45° field of view, 2352x1568: 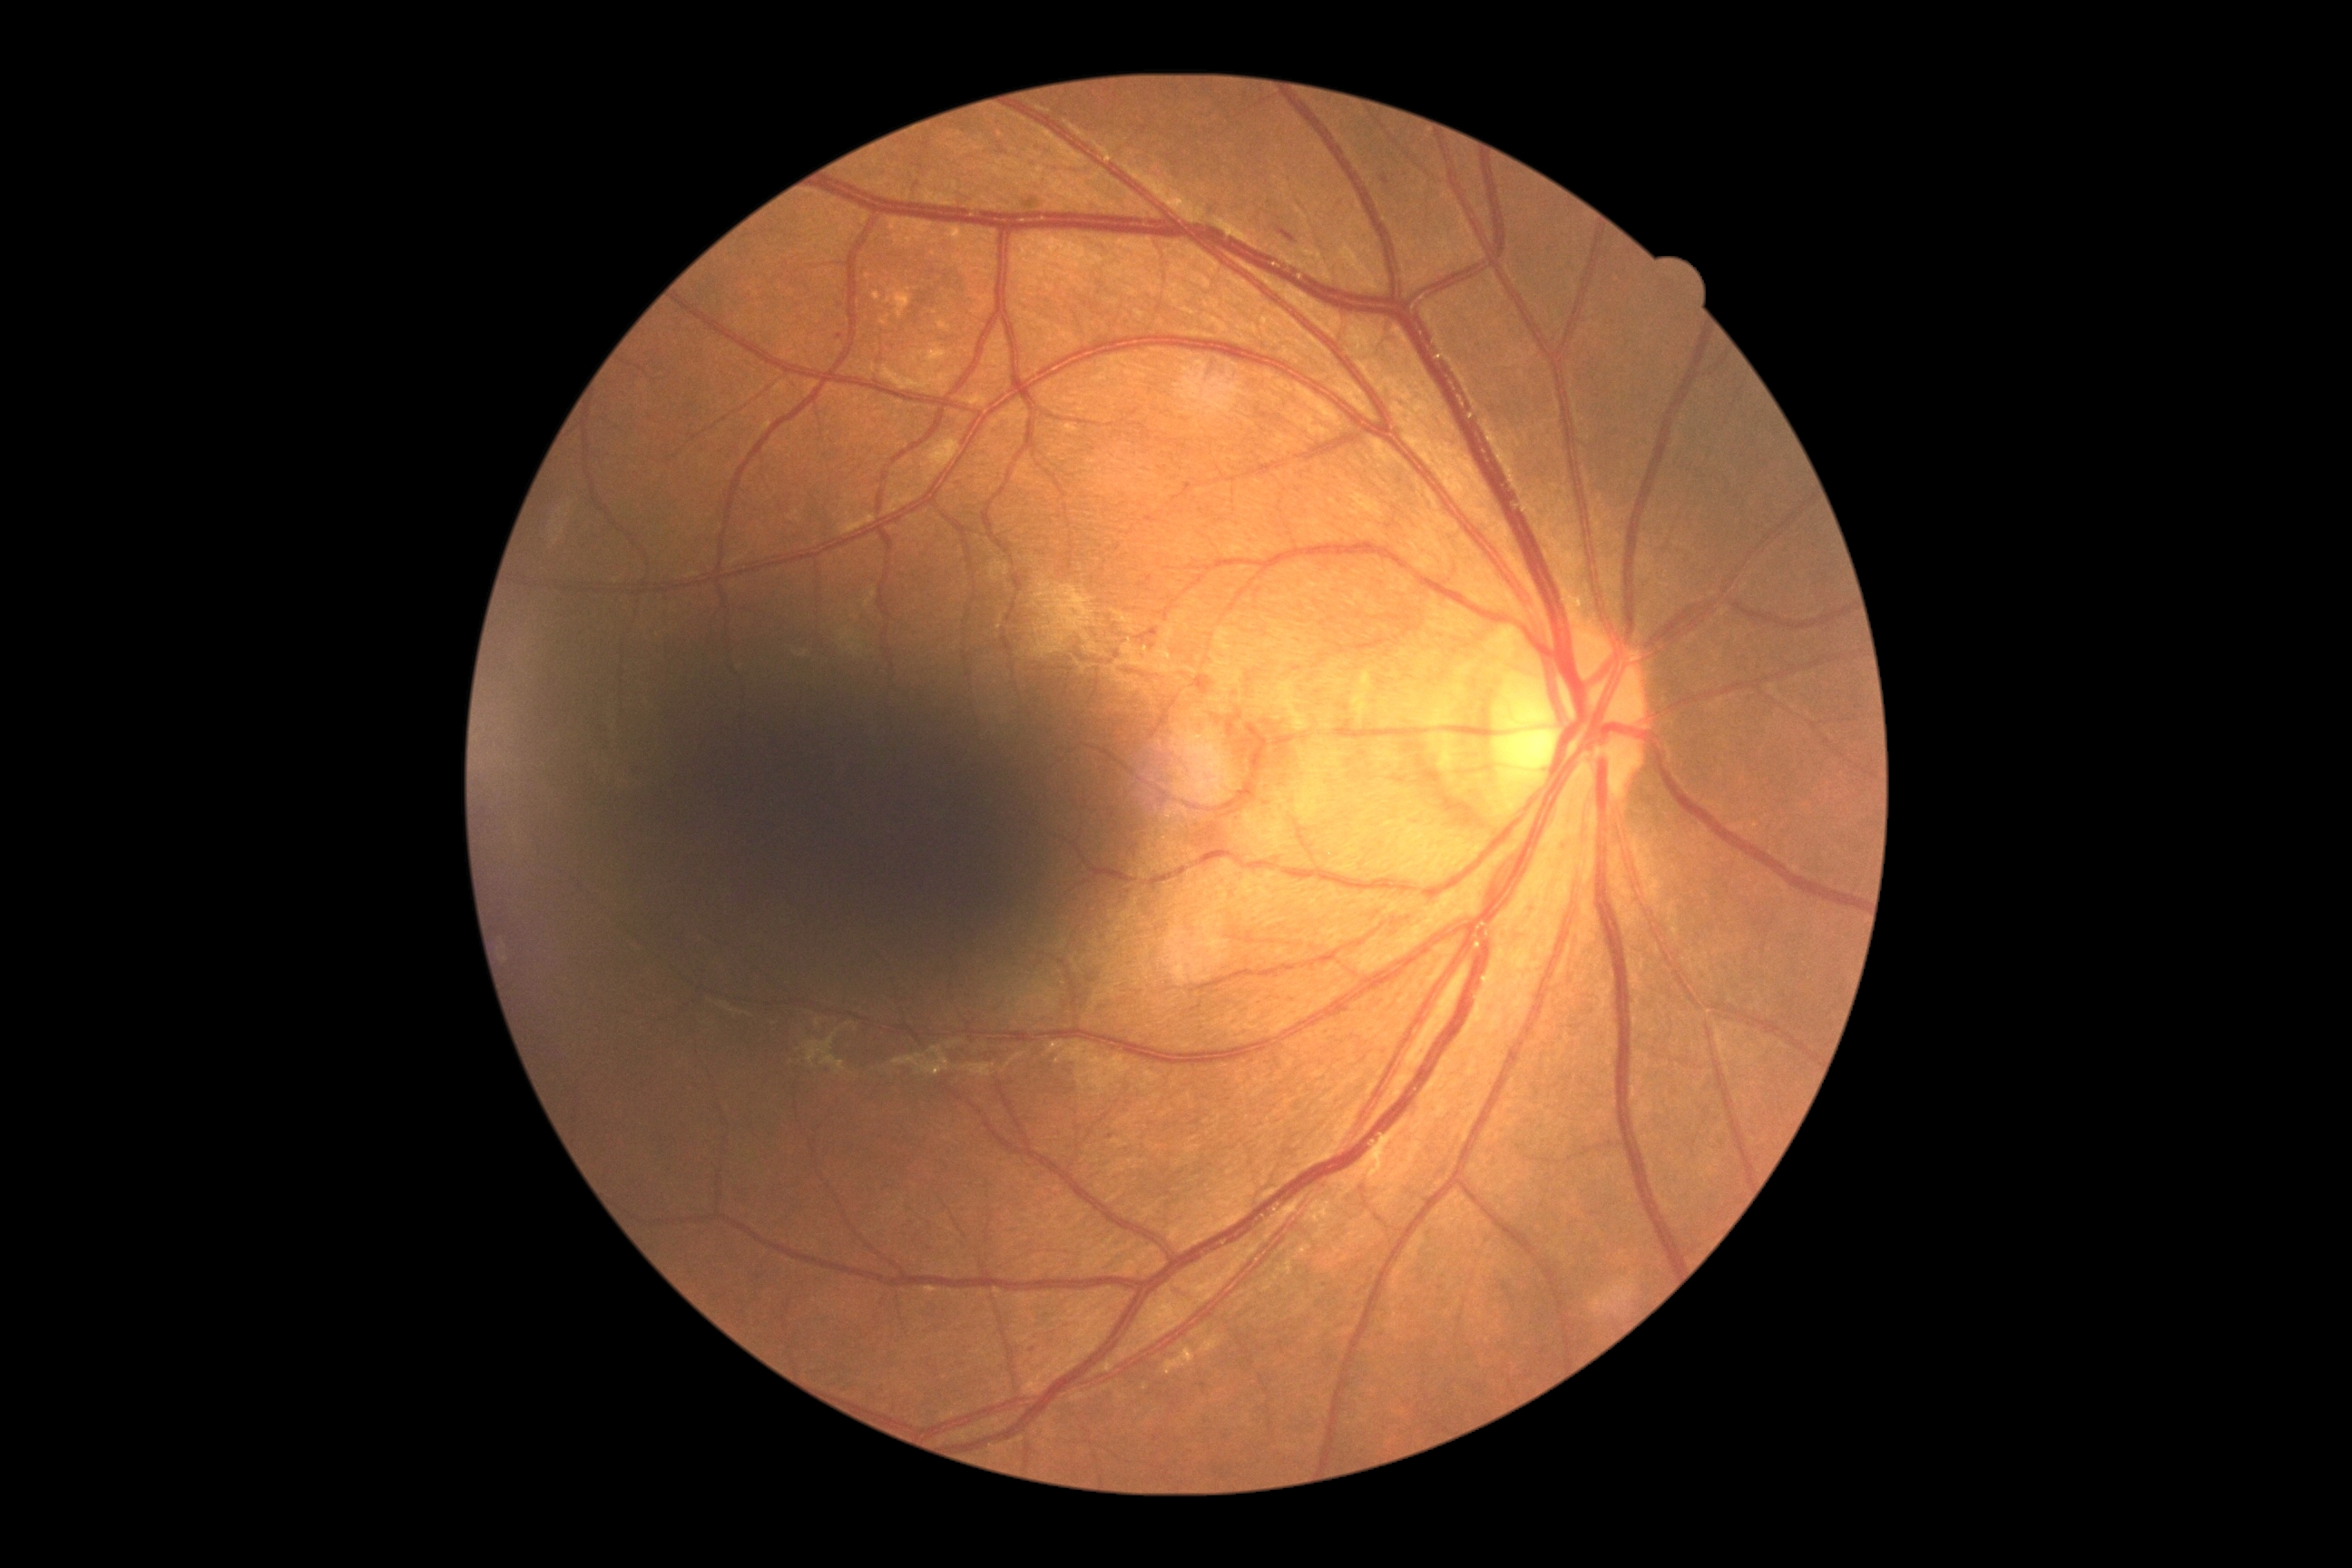

DR stage: 2/4.